CFP, 1932 by 1932 pixels, 45° FOV
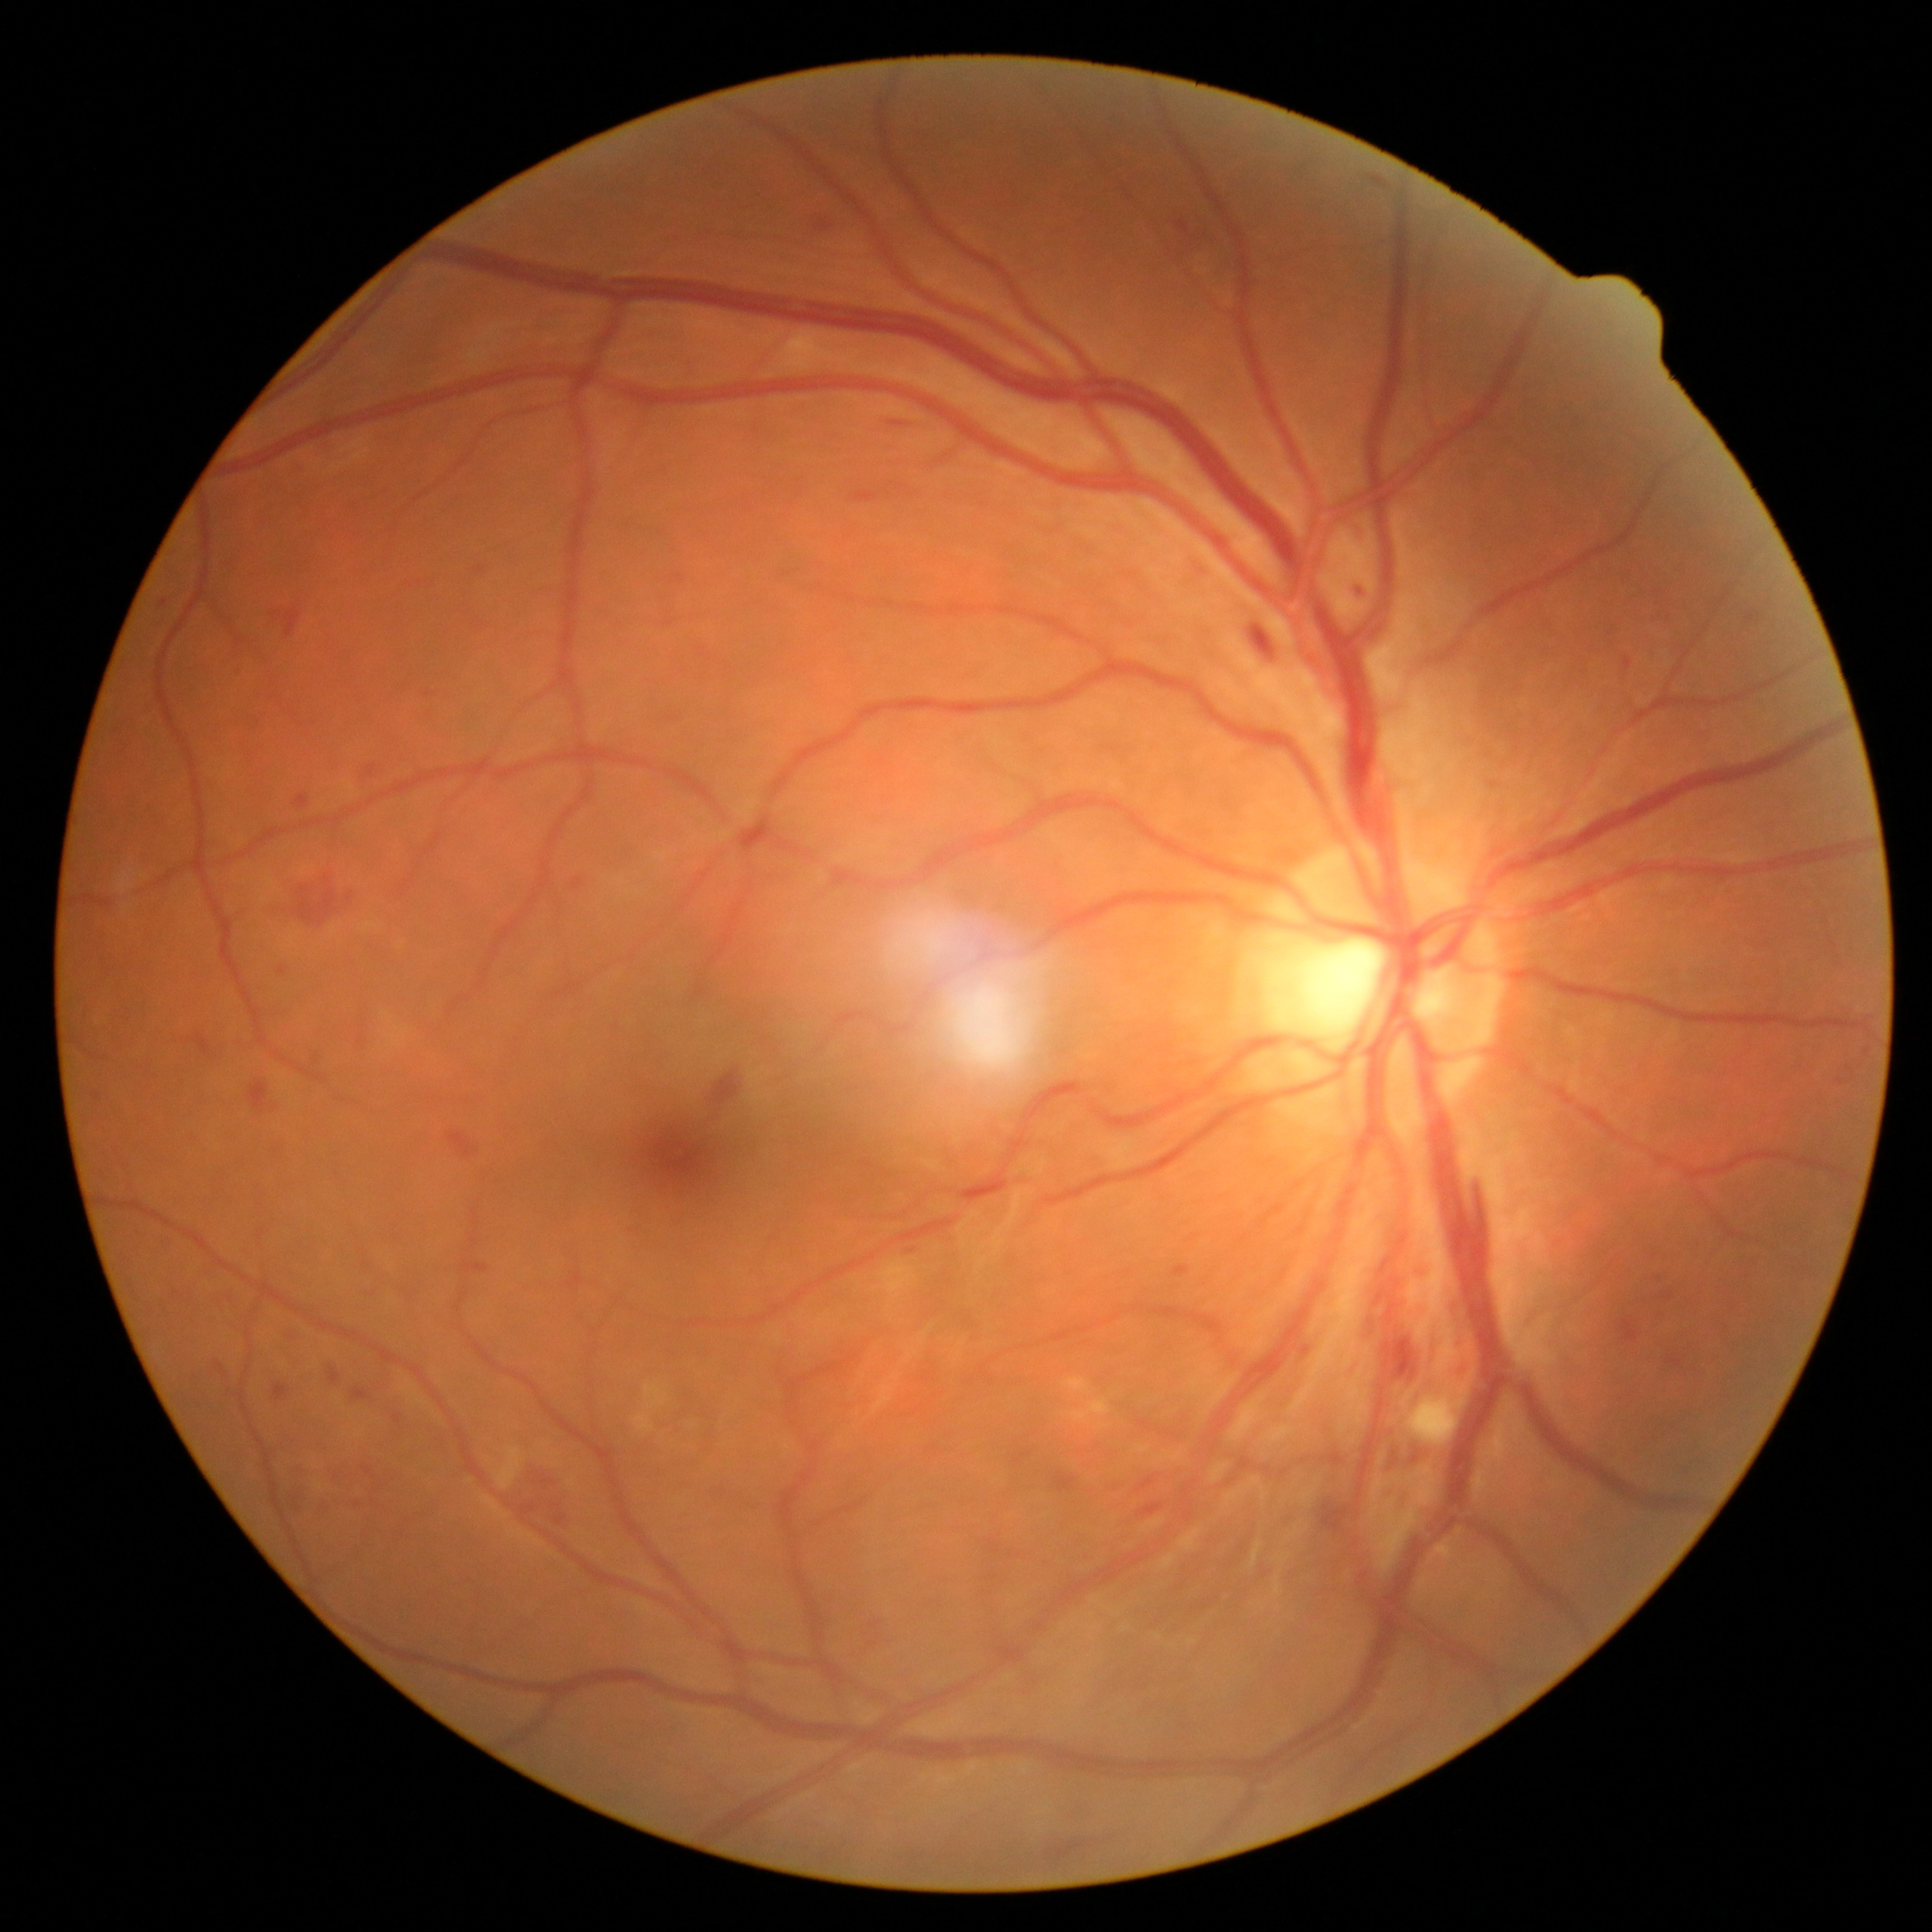 Findings:
• diabetic retinopathy grade: moderate NPDR (2)